45-degree field of view.
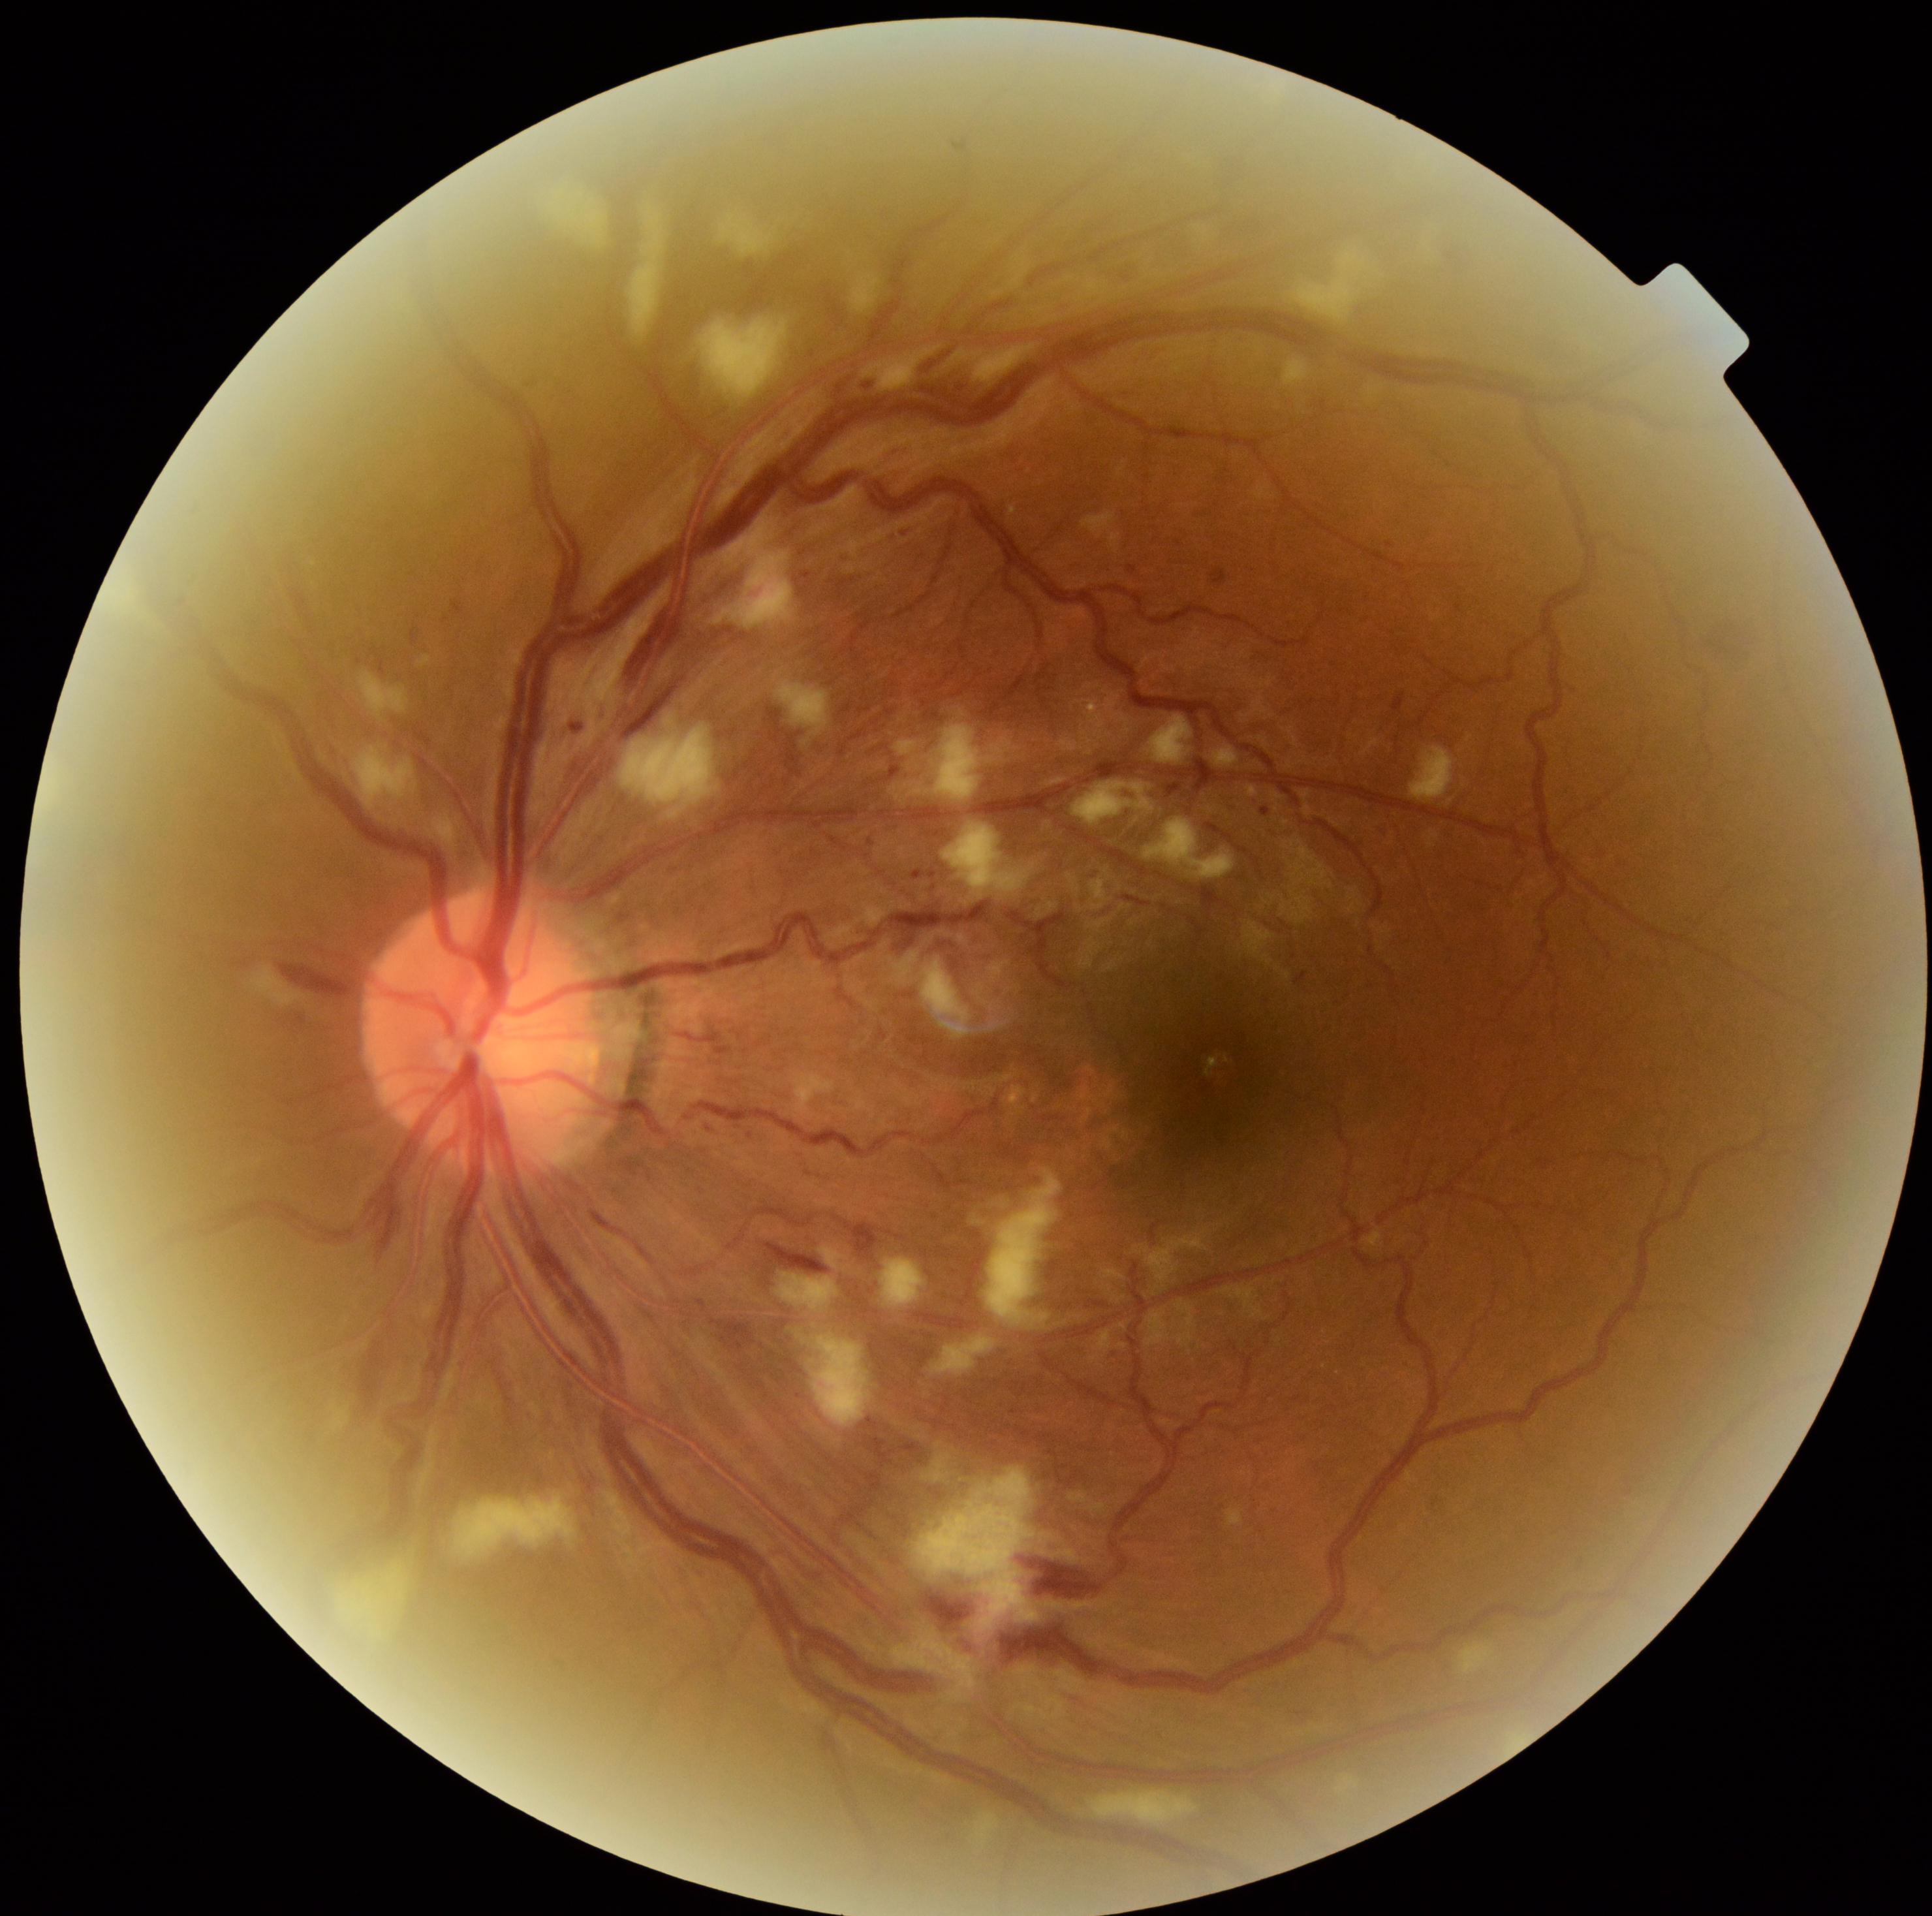

Retinopathy grade is 2 (moderate NPDR).